1240 by 1240 pixels. Phoenix ICON, 100° FOV. Infant wide-field retinal image: 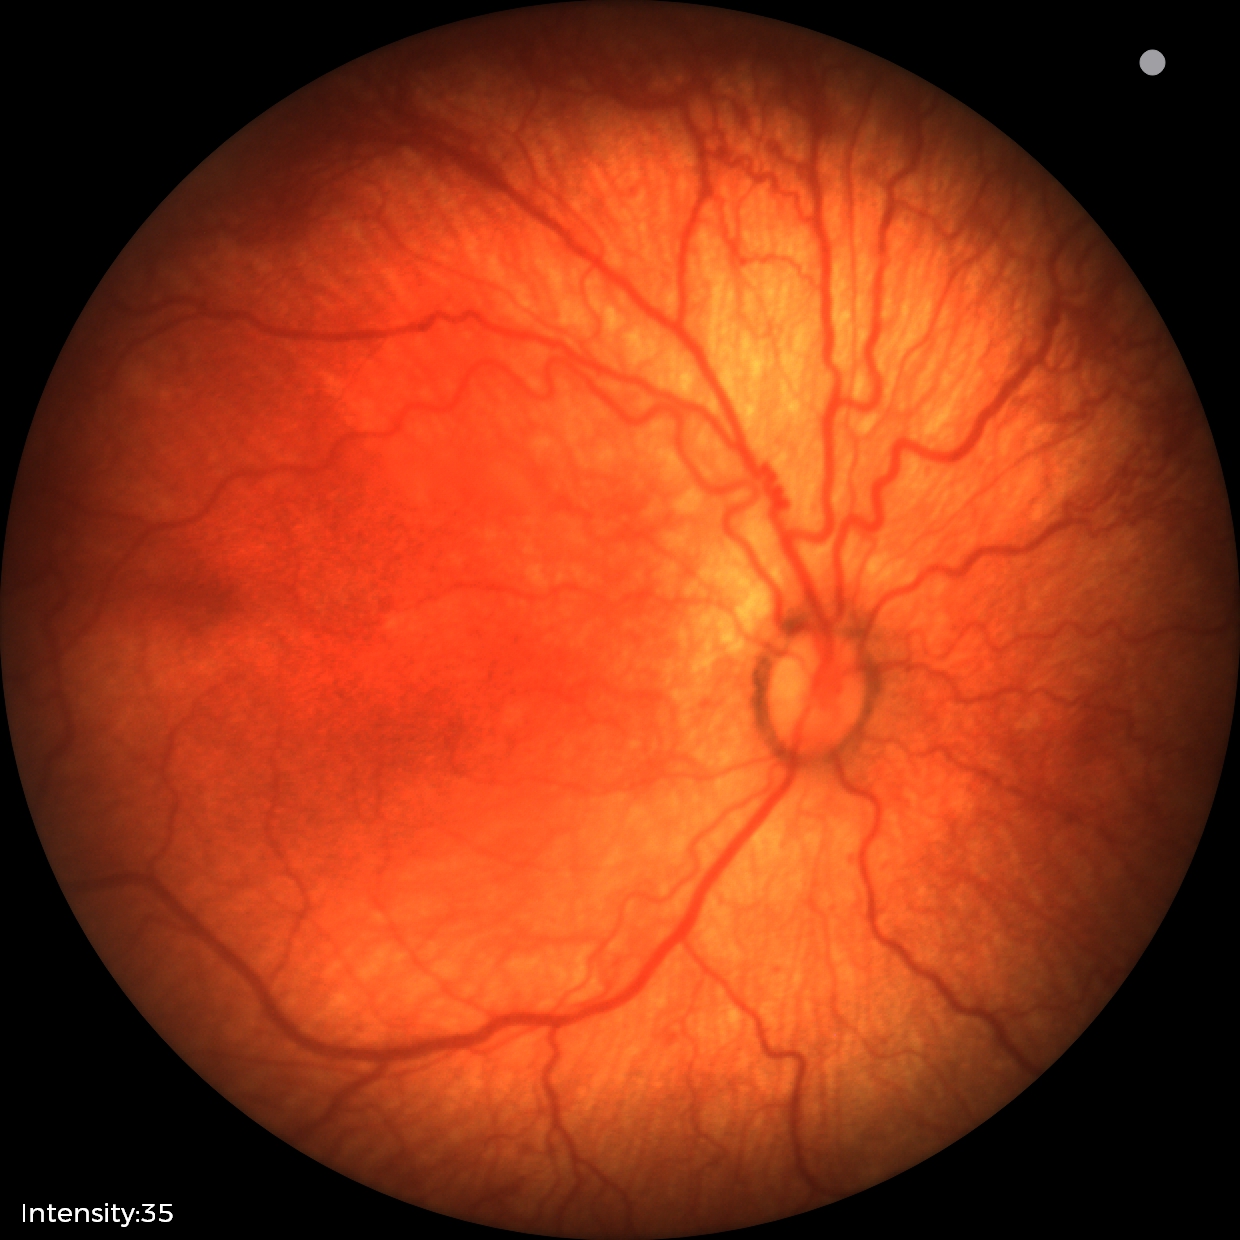
Screening examination consistent with ROP stage 1. Plus disease was diagnosed.